Fundus photo: 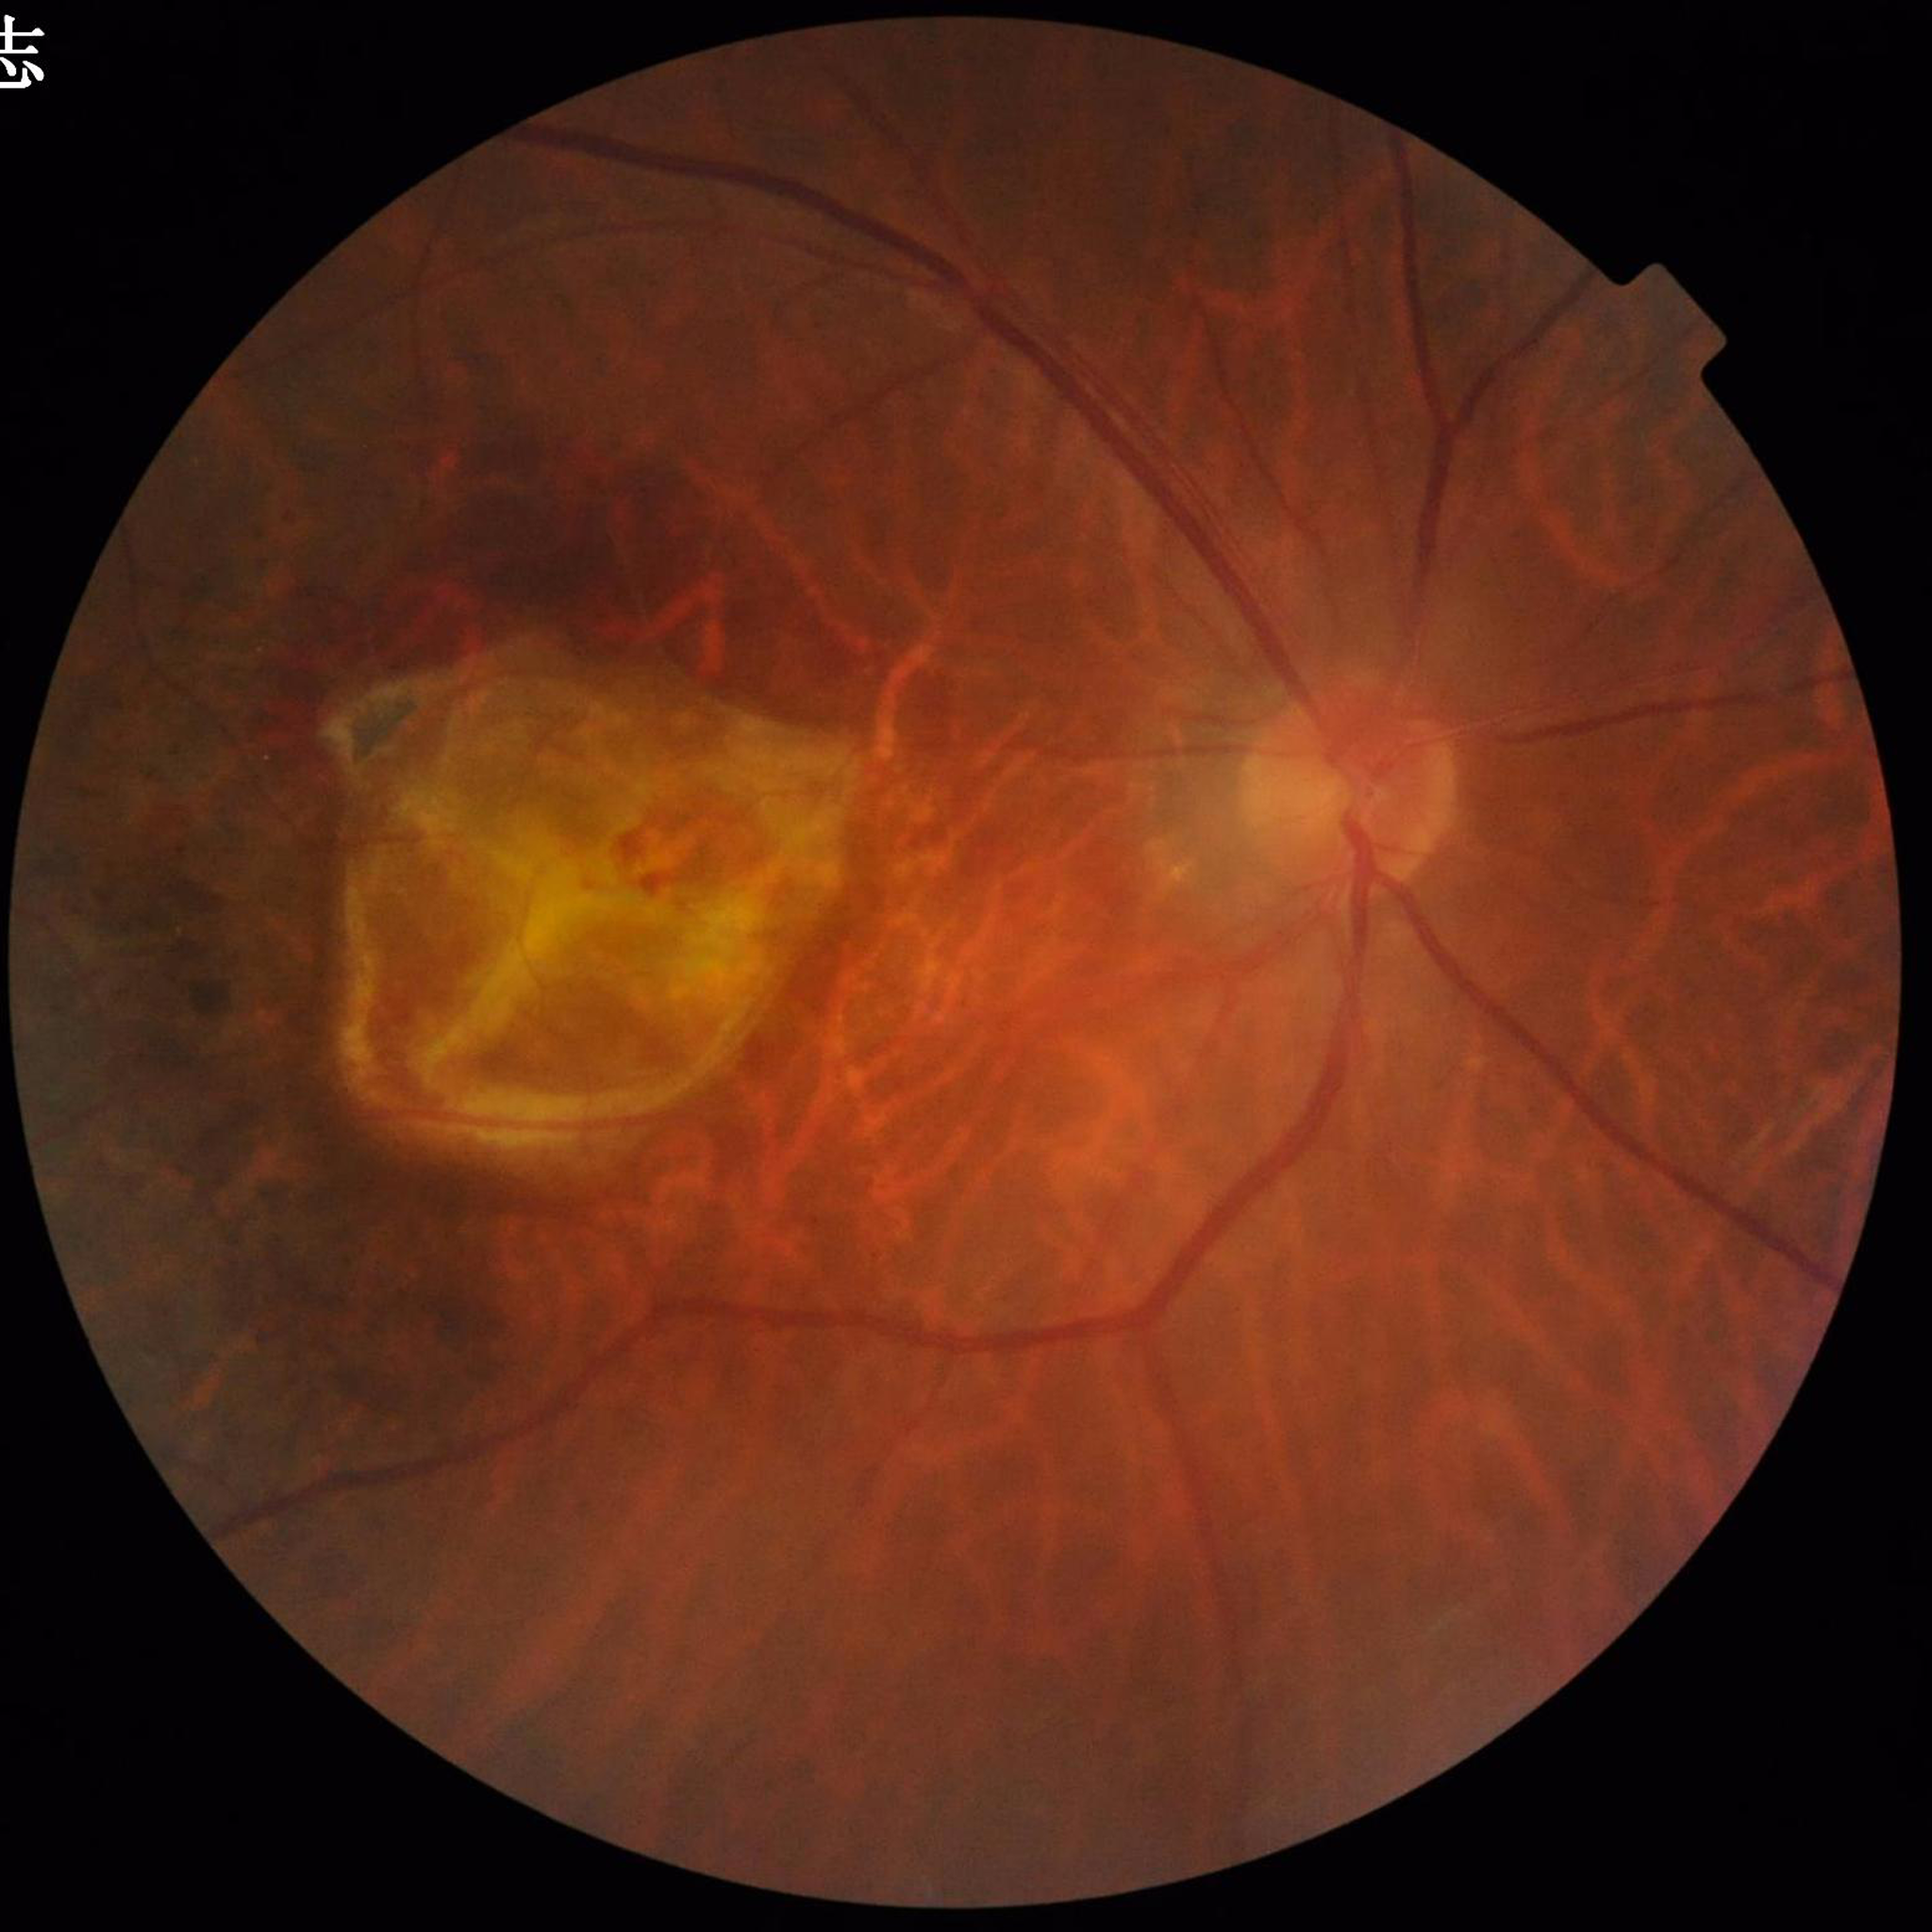
diagnosis: AMD
image_quality: satisfactory